Color fundus photograph: 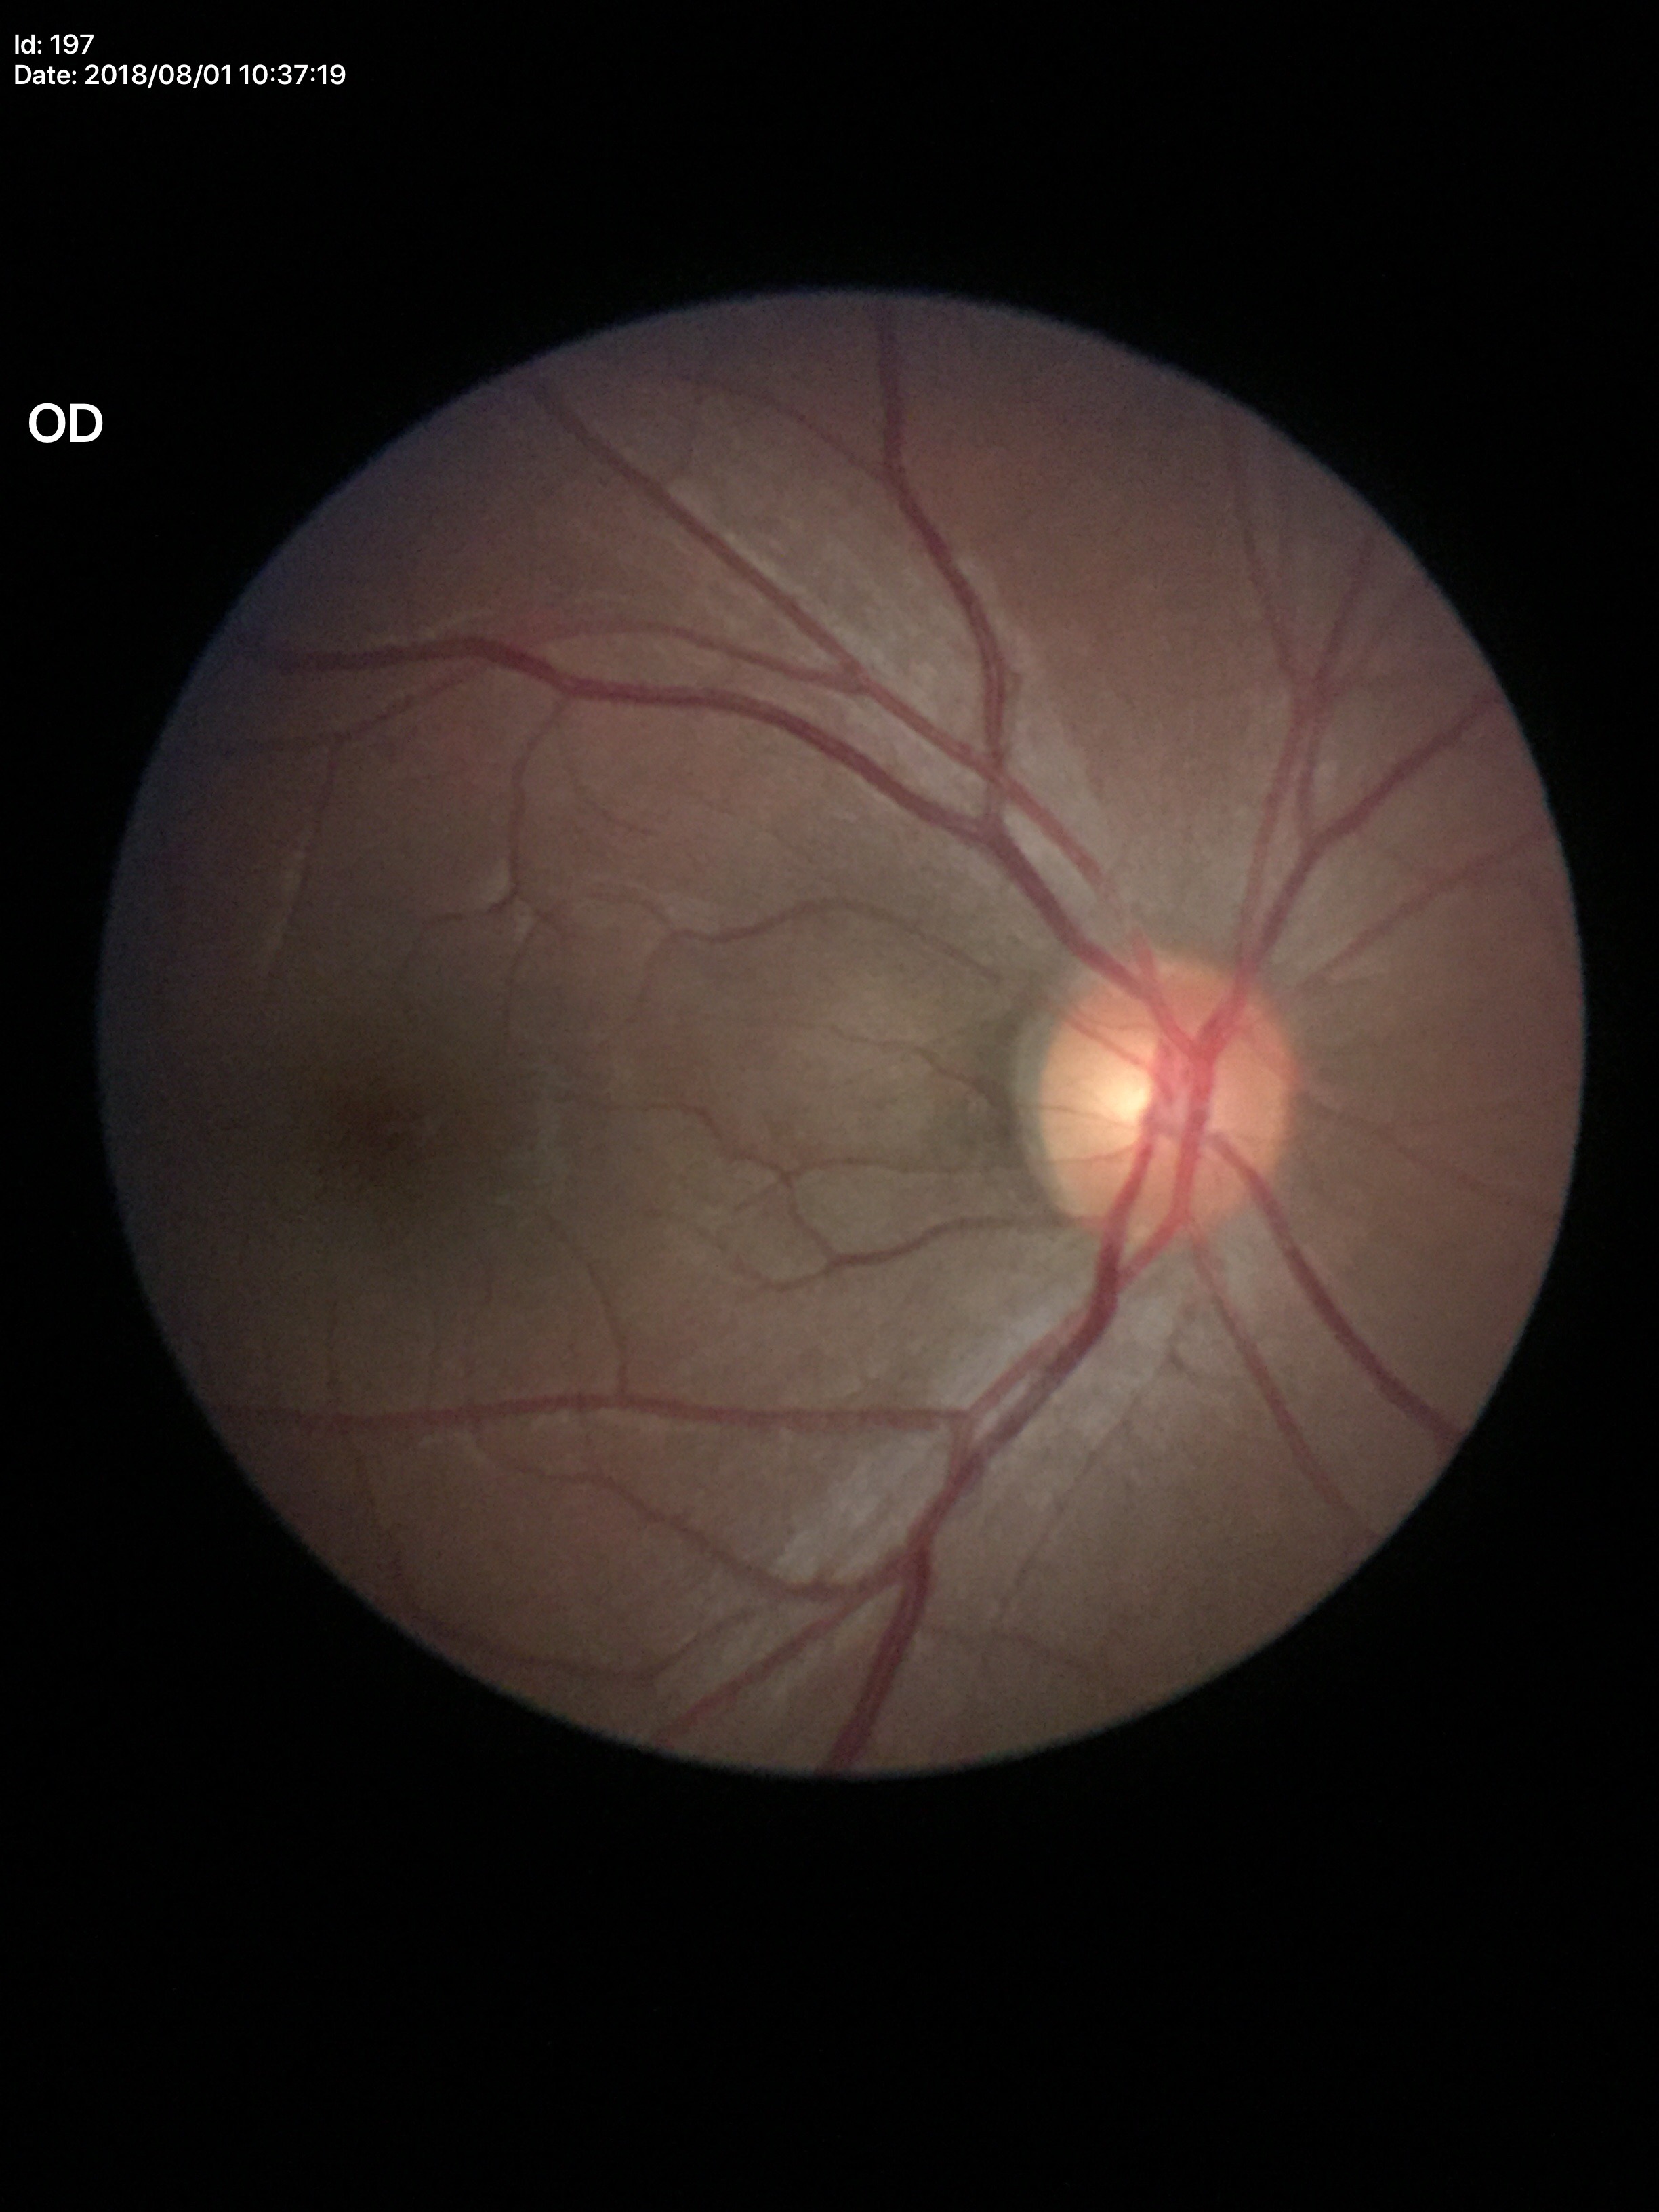
Glaucoma decision: not suspect (unanimous normal call).
Vertical CDR: 0.46.